CFP:
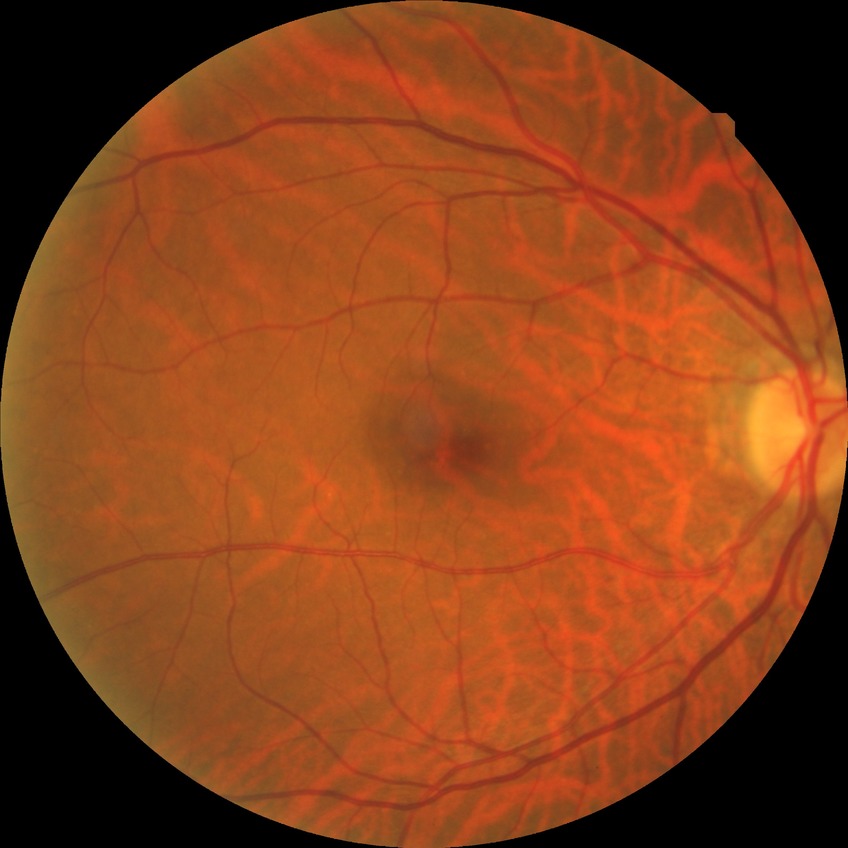

diabetic retinopathy (DR): no diabetic retinopathy (NDR)